Centered on the macula. CFP
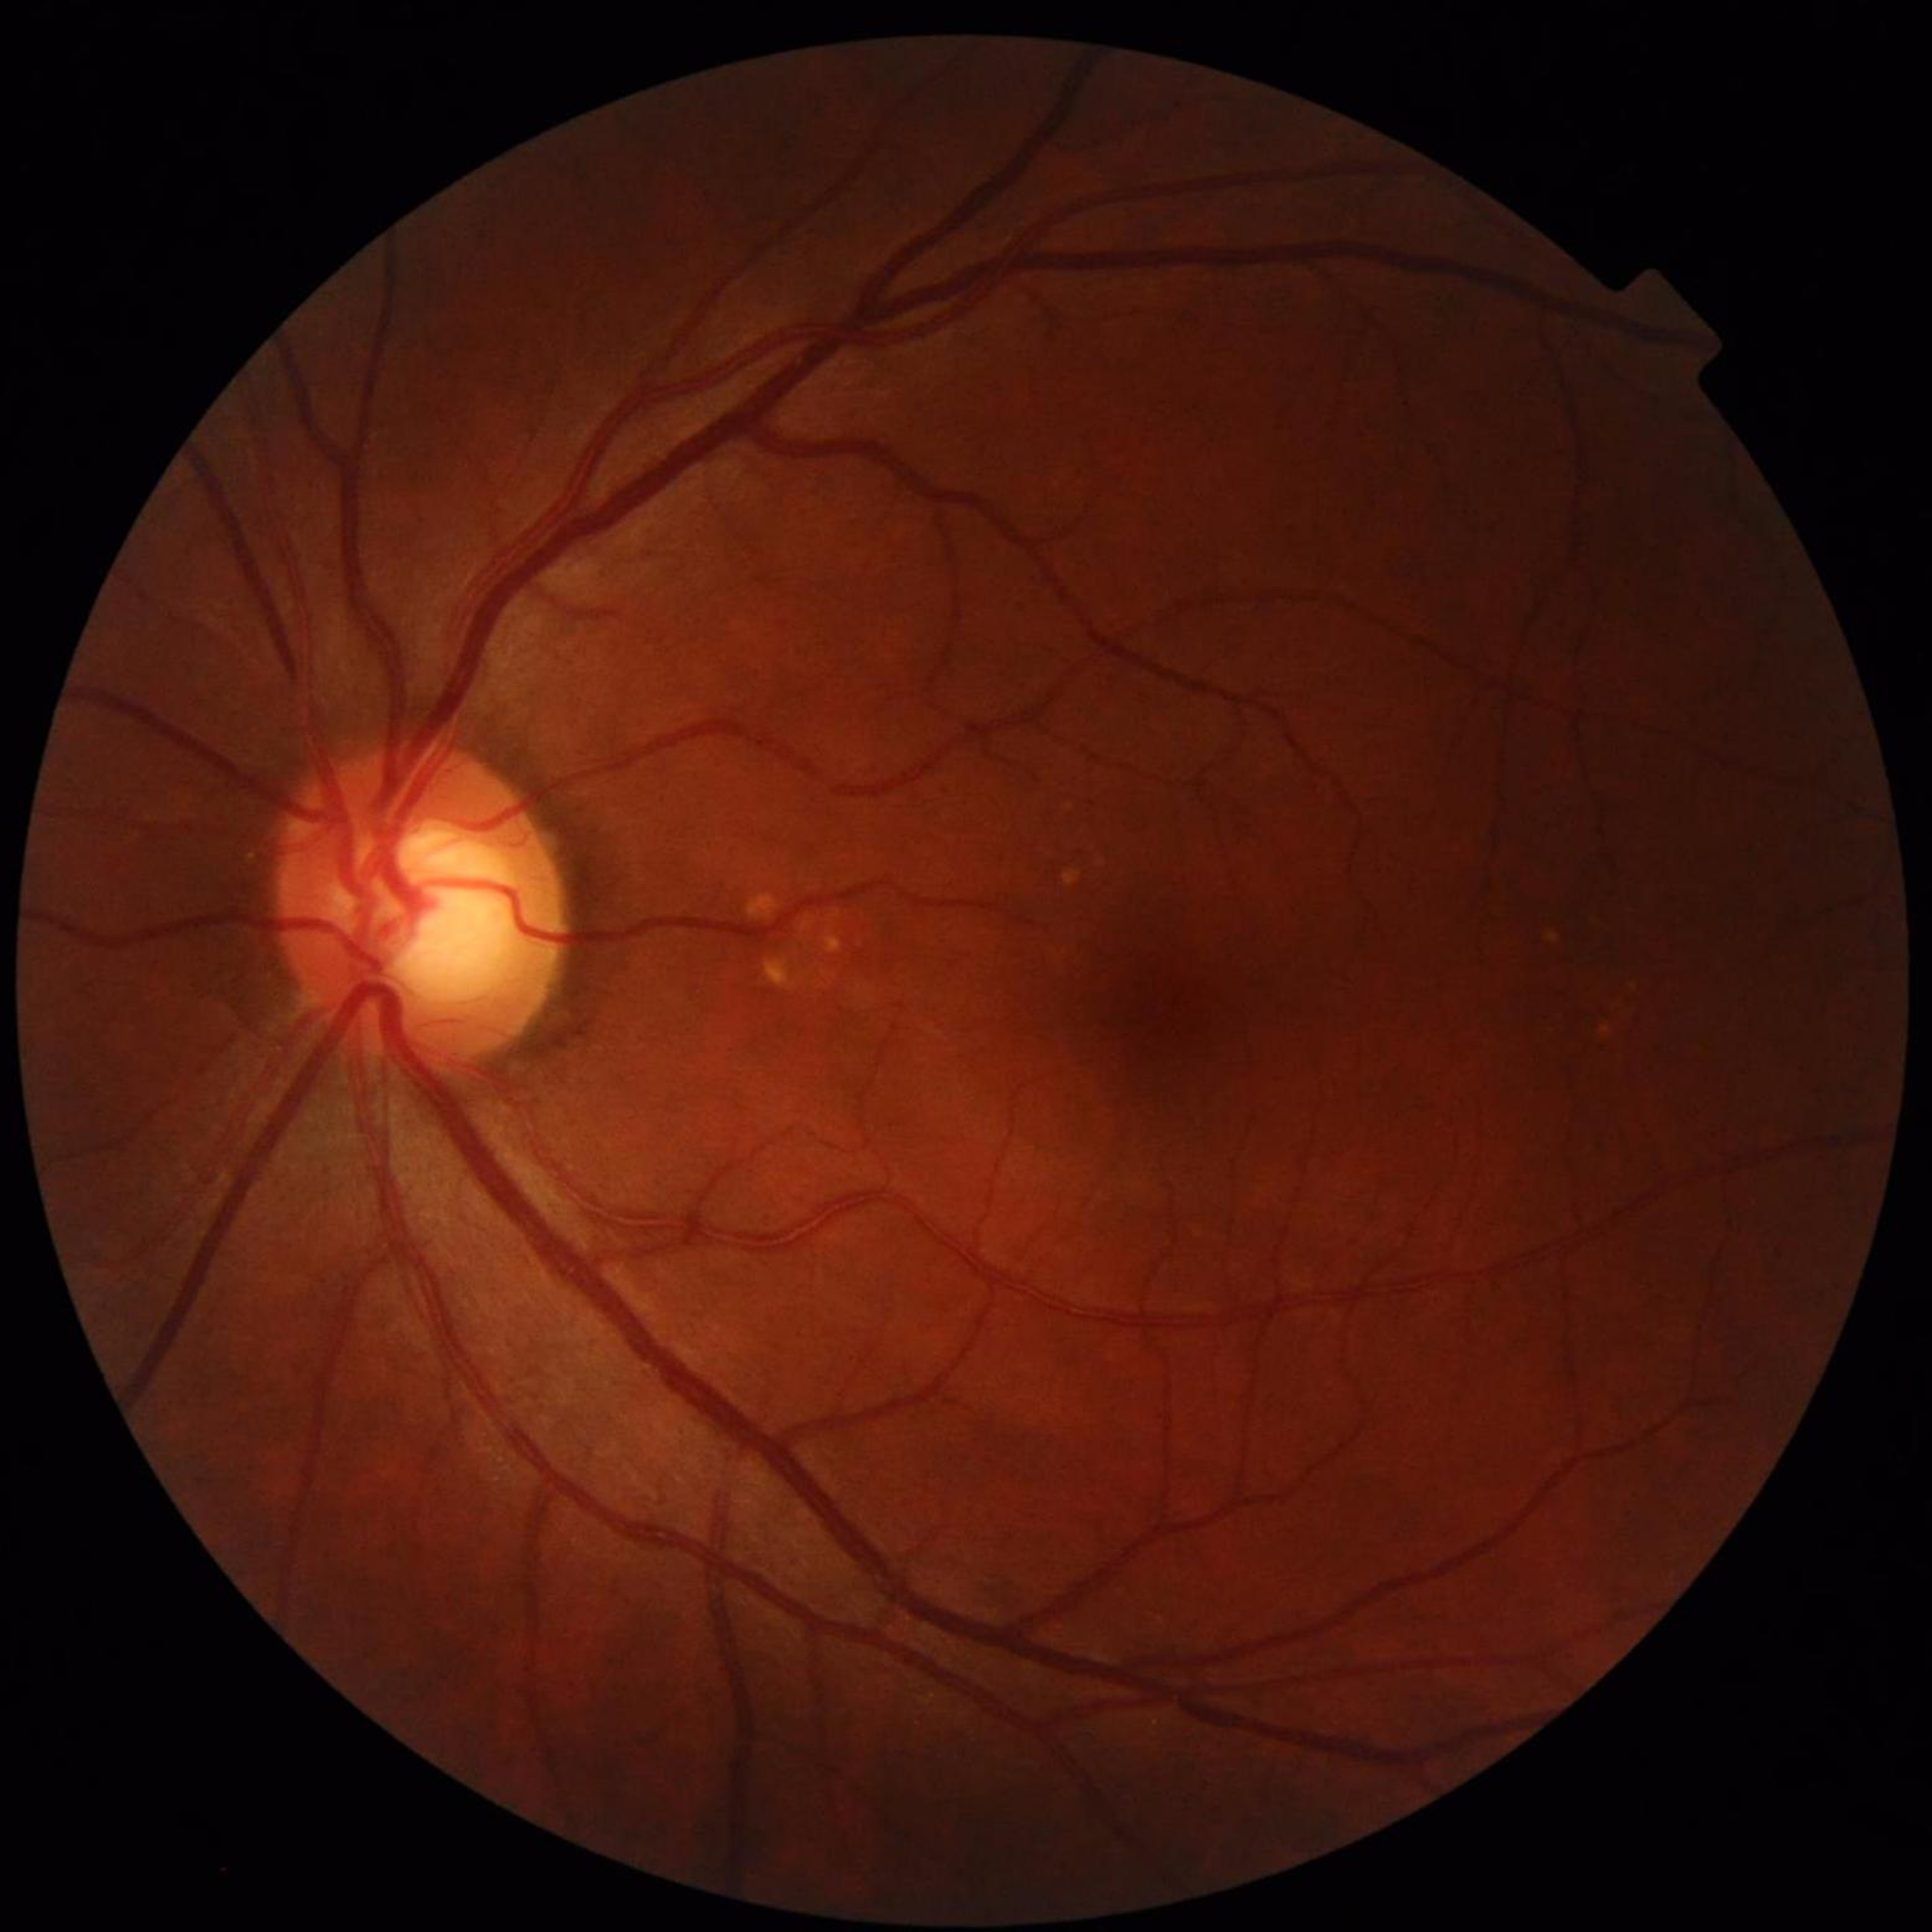

Condition = glaucoma.